Infant wide-field fundus photograph. 1440x1080px. Captured with the Natus RetCam Envision (130° field of view): 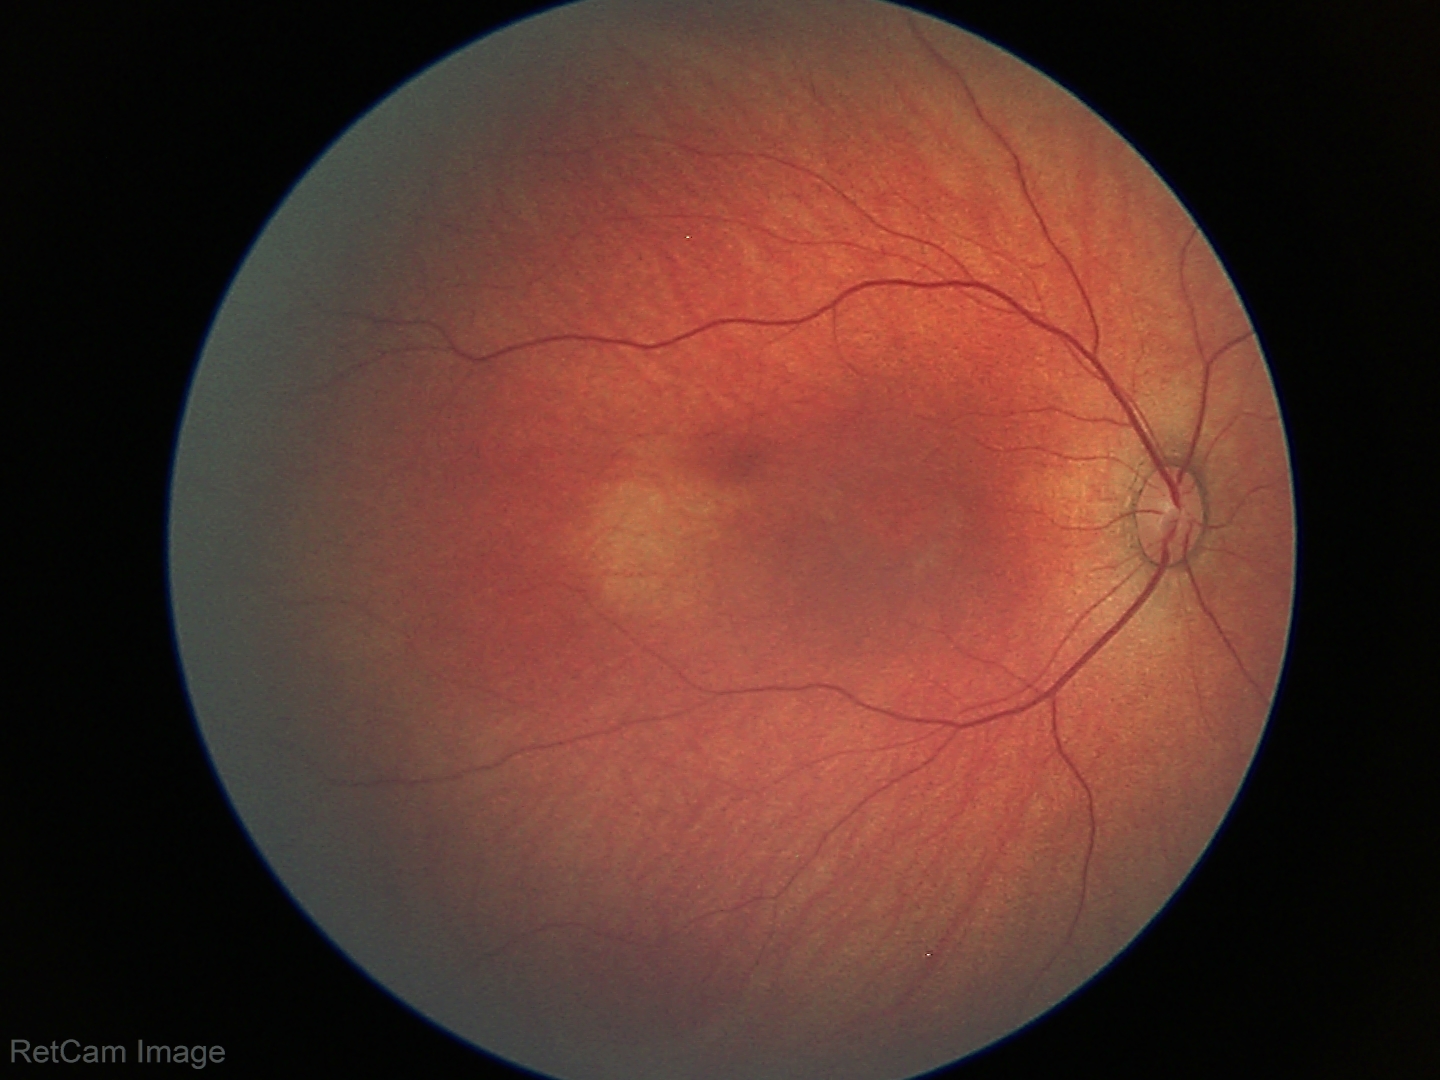
Assessment: normal fundus examination.